2352 x 1568 pixels. CFP: 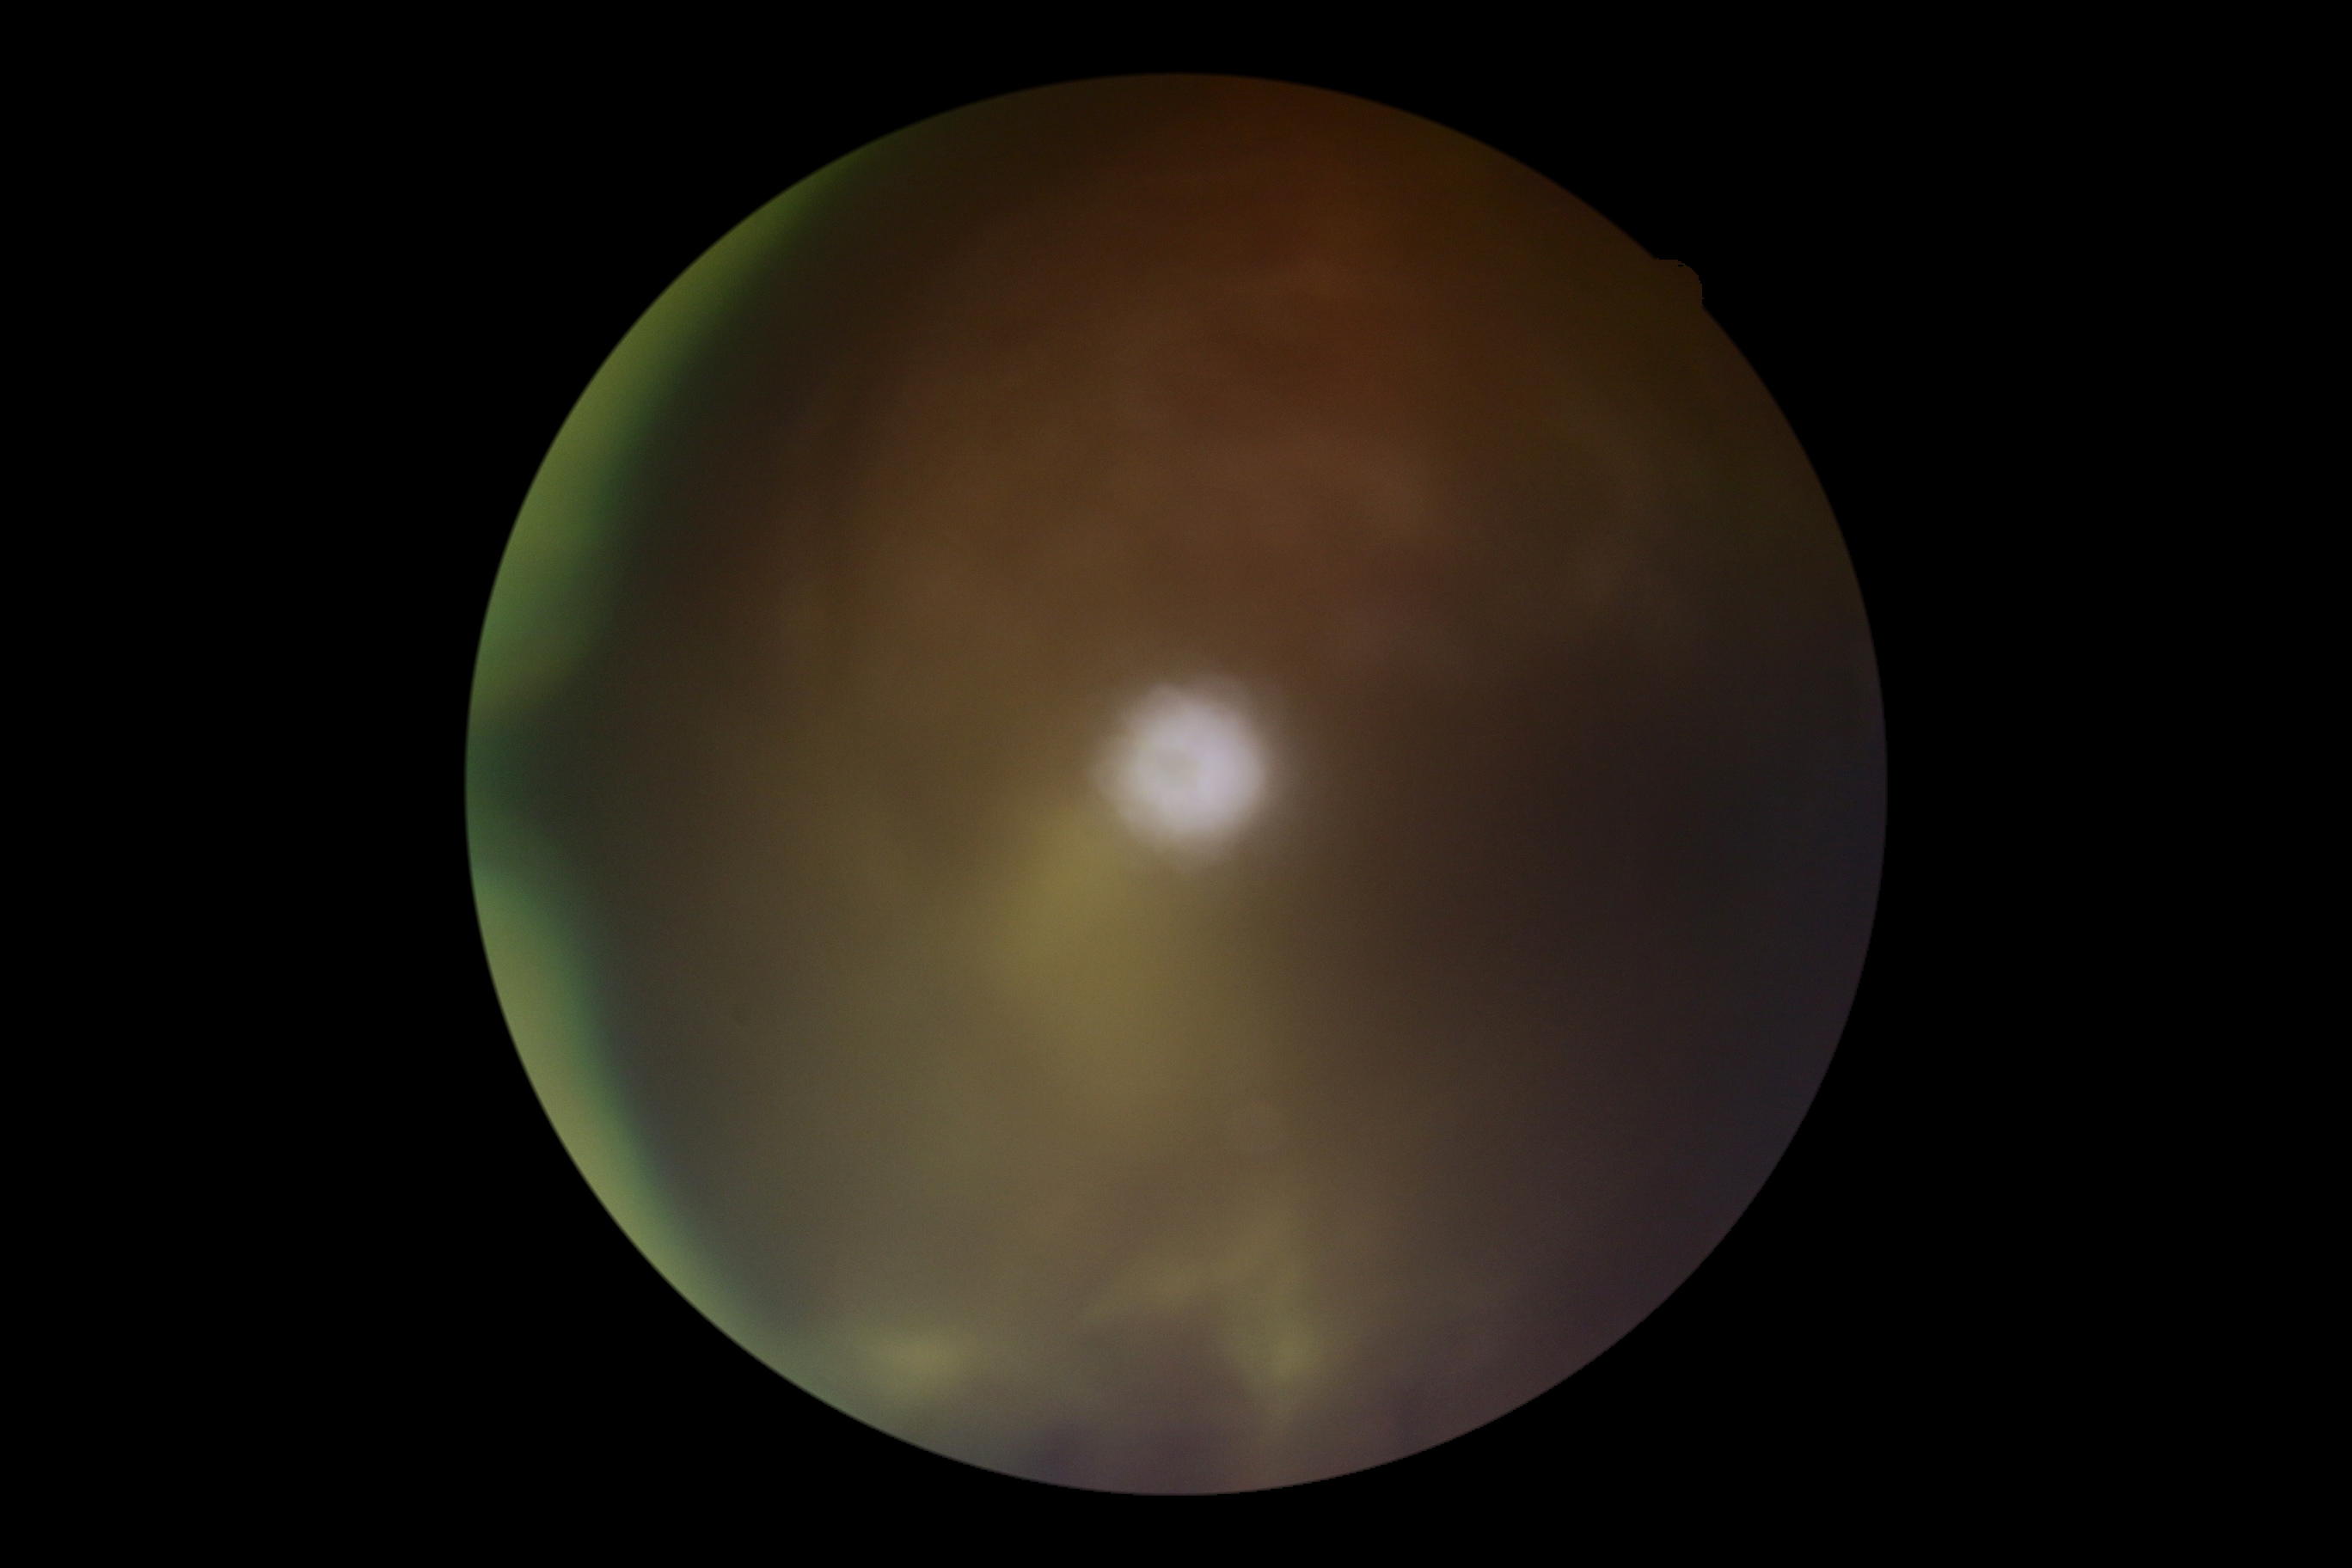
Diabetic retinopathy (DR): ungradable.